Modified Davis grading: 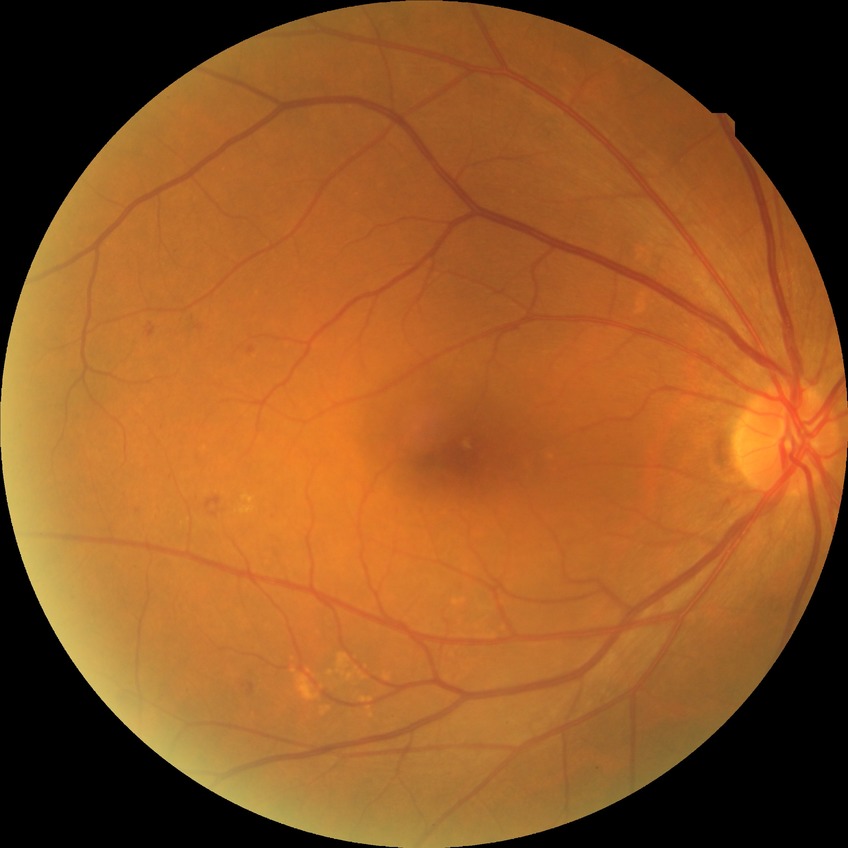

Diabetic retinopathy (DR) is simple diabetic retinopathy (SDR).